Fundus photo: 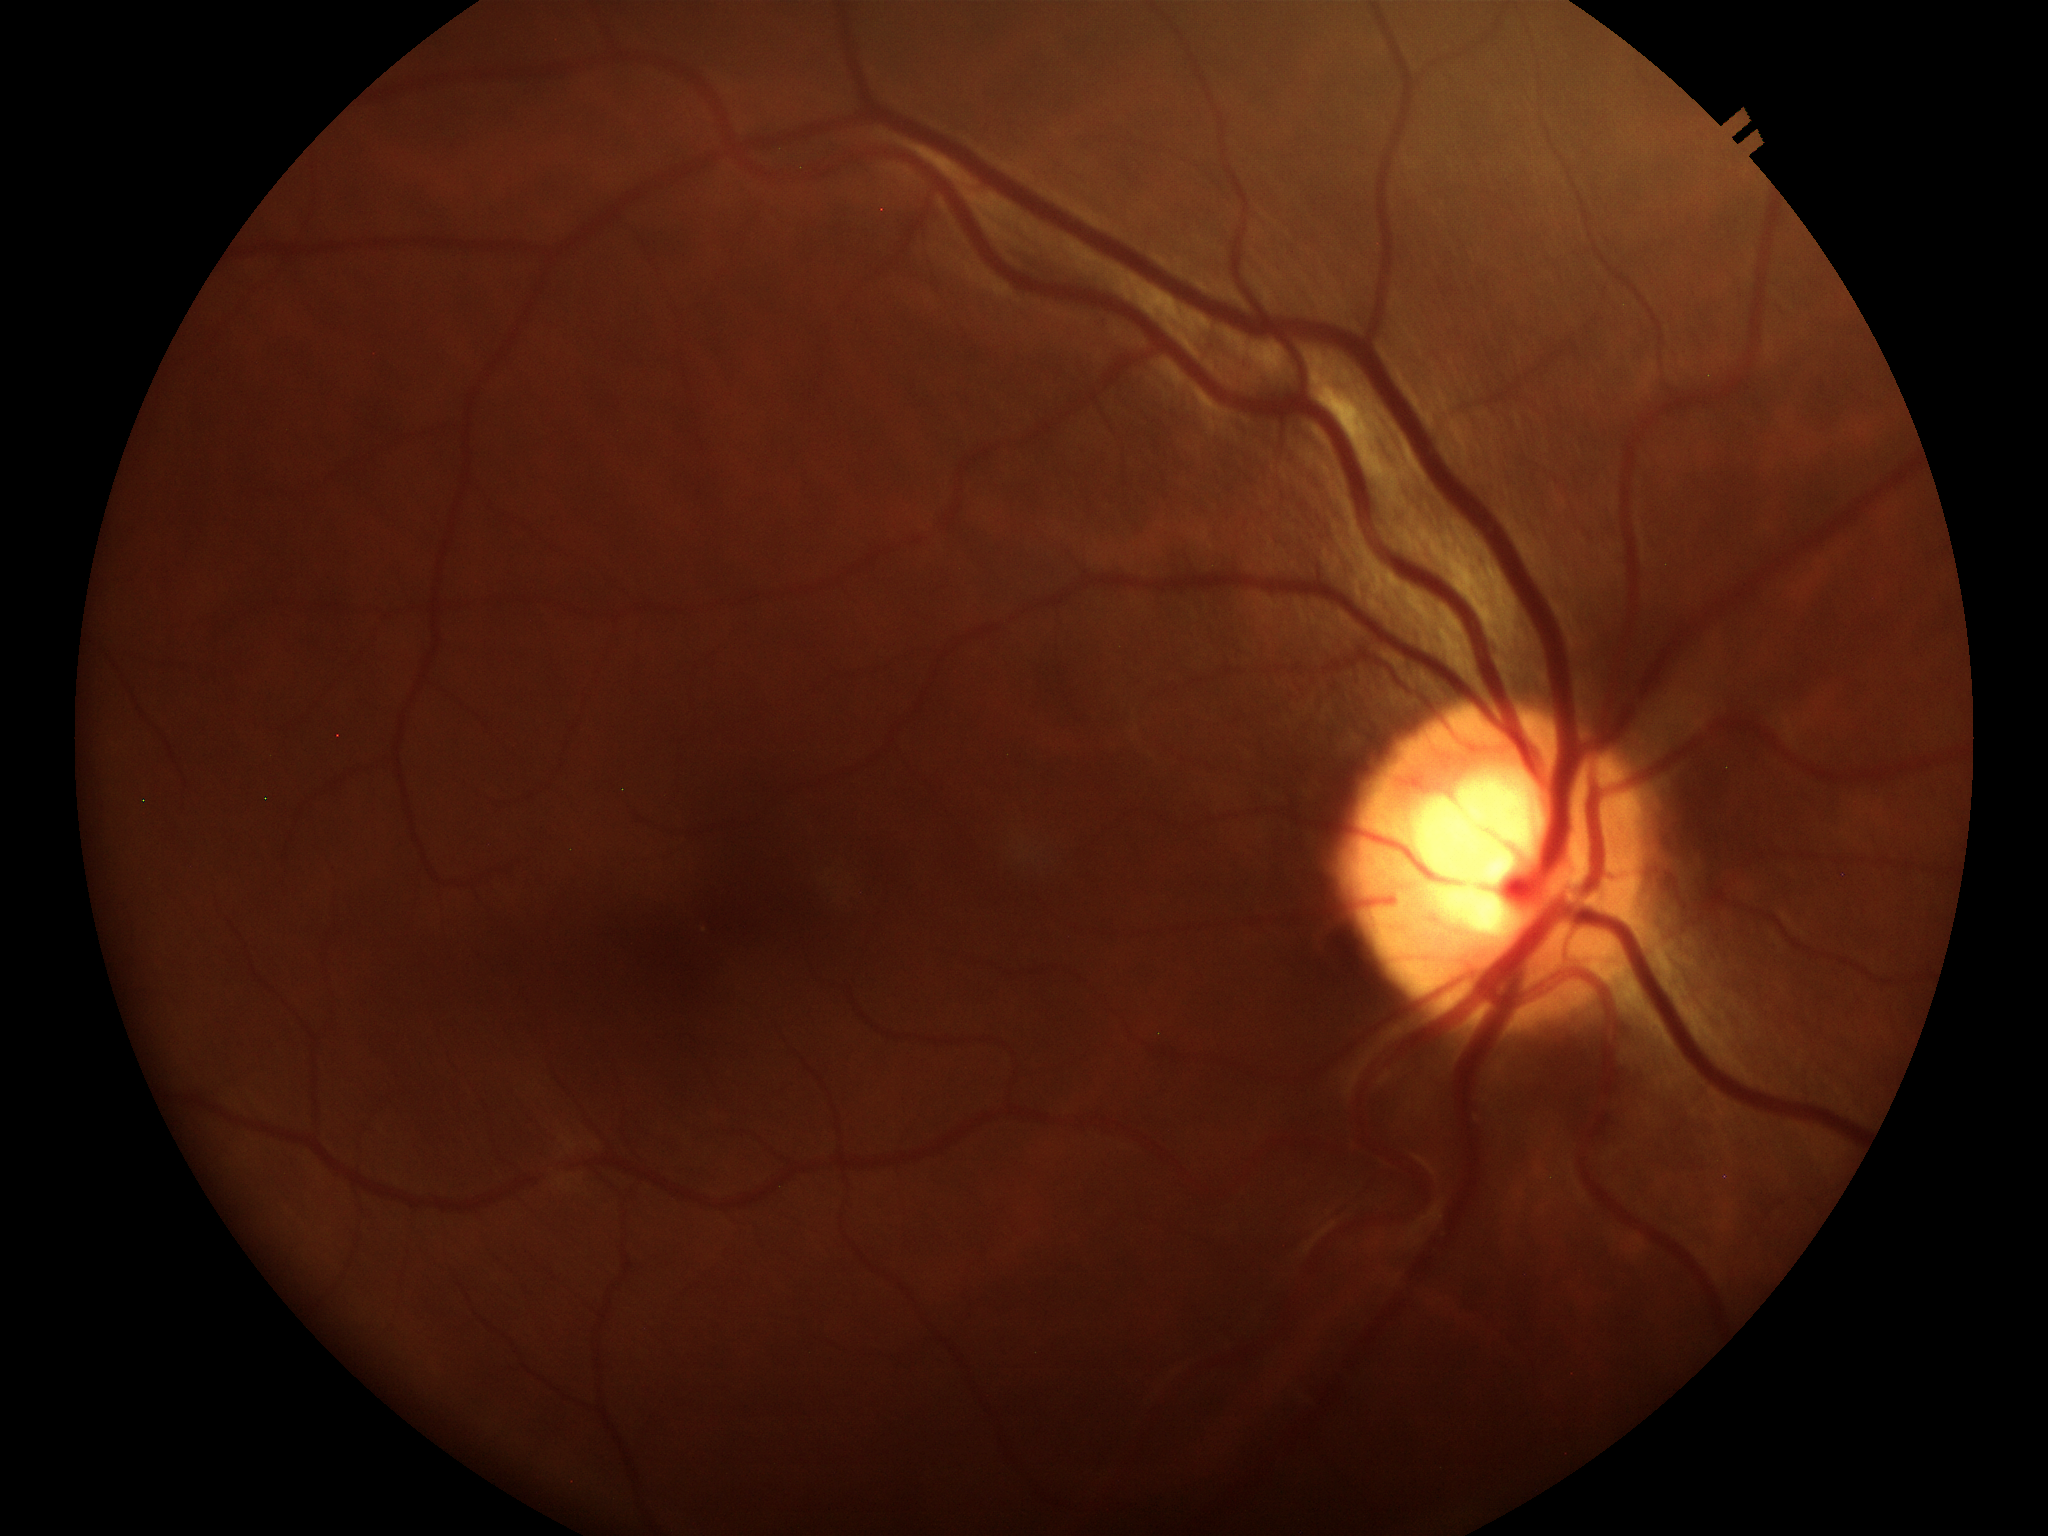 Q: Is there glaucoma suspicion?
A: no suspicious findings
Q: Vertical CDR?
A: 0.58
Q: What is the HCDR?
A: 0.62